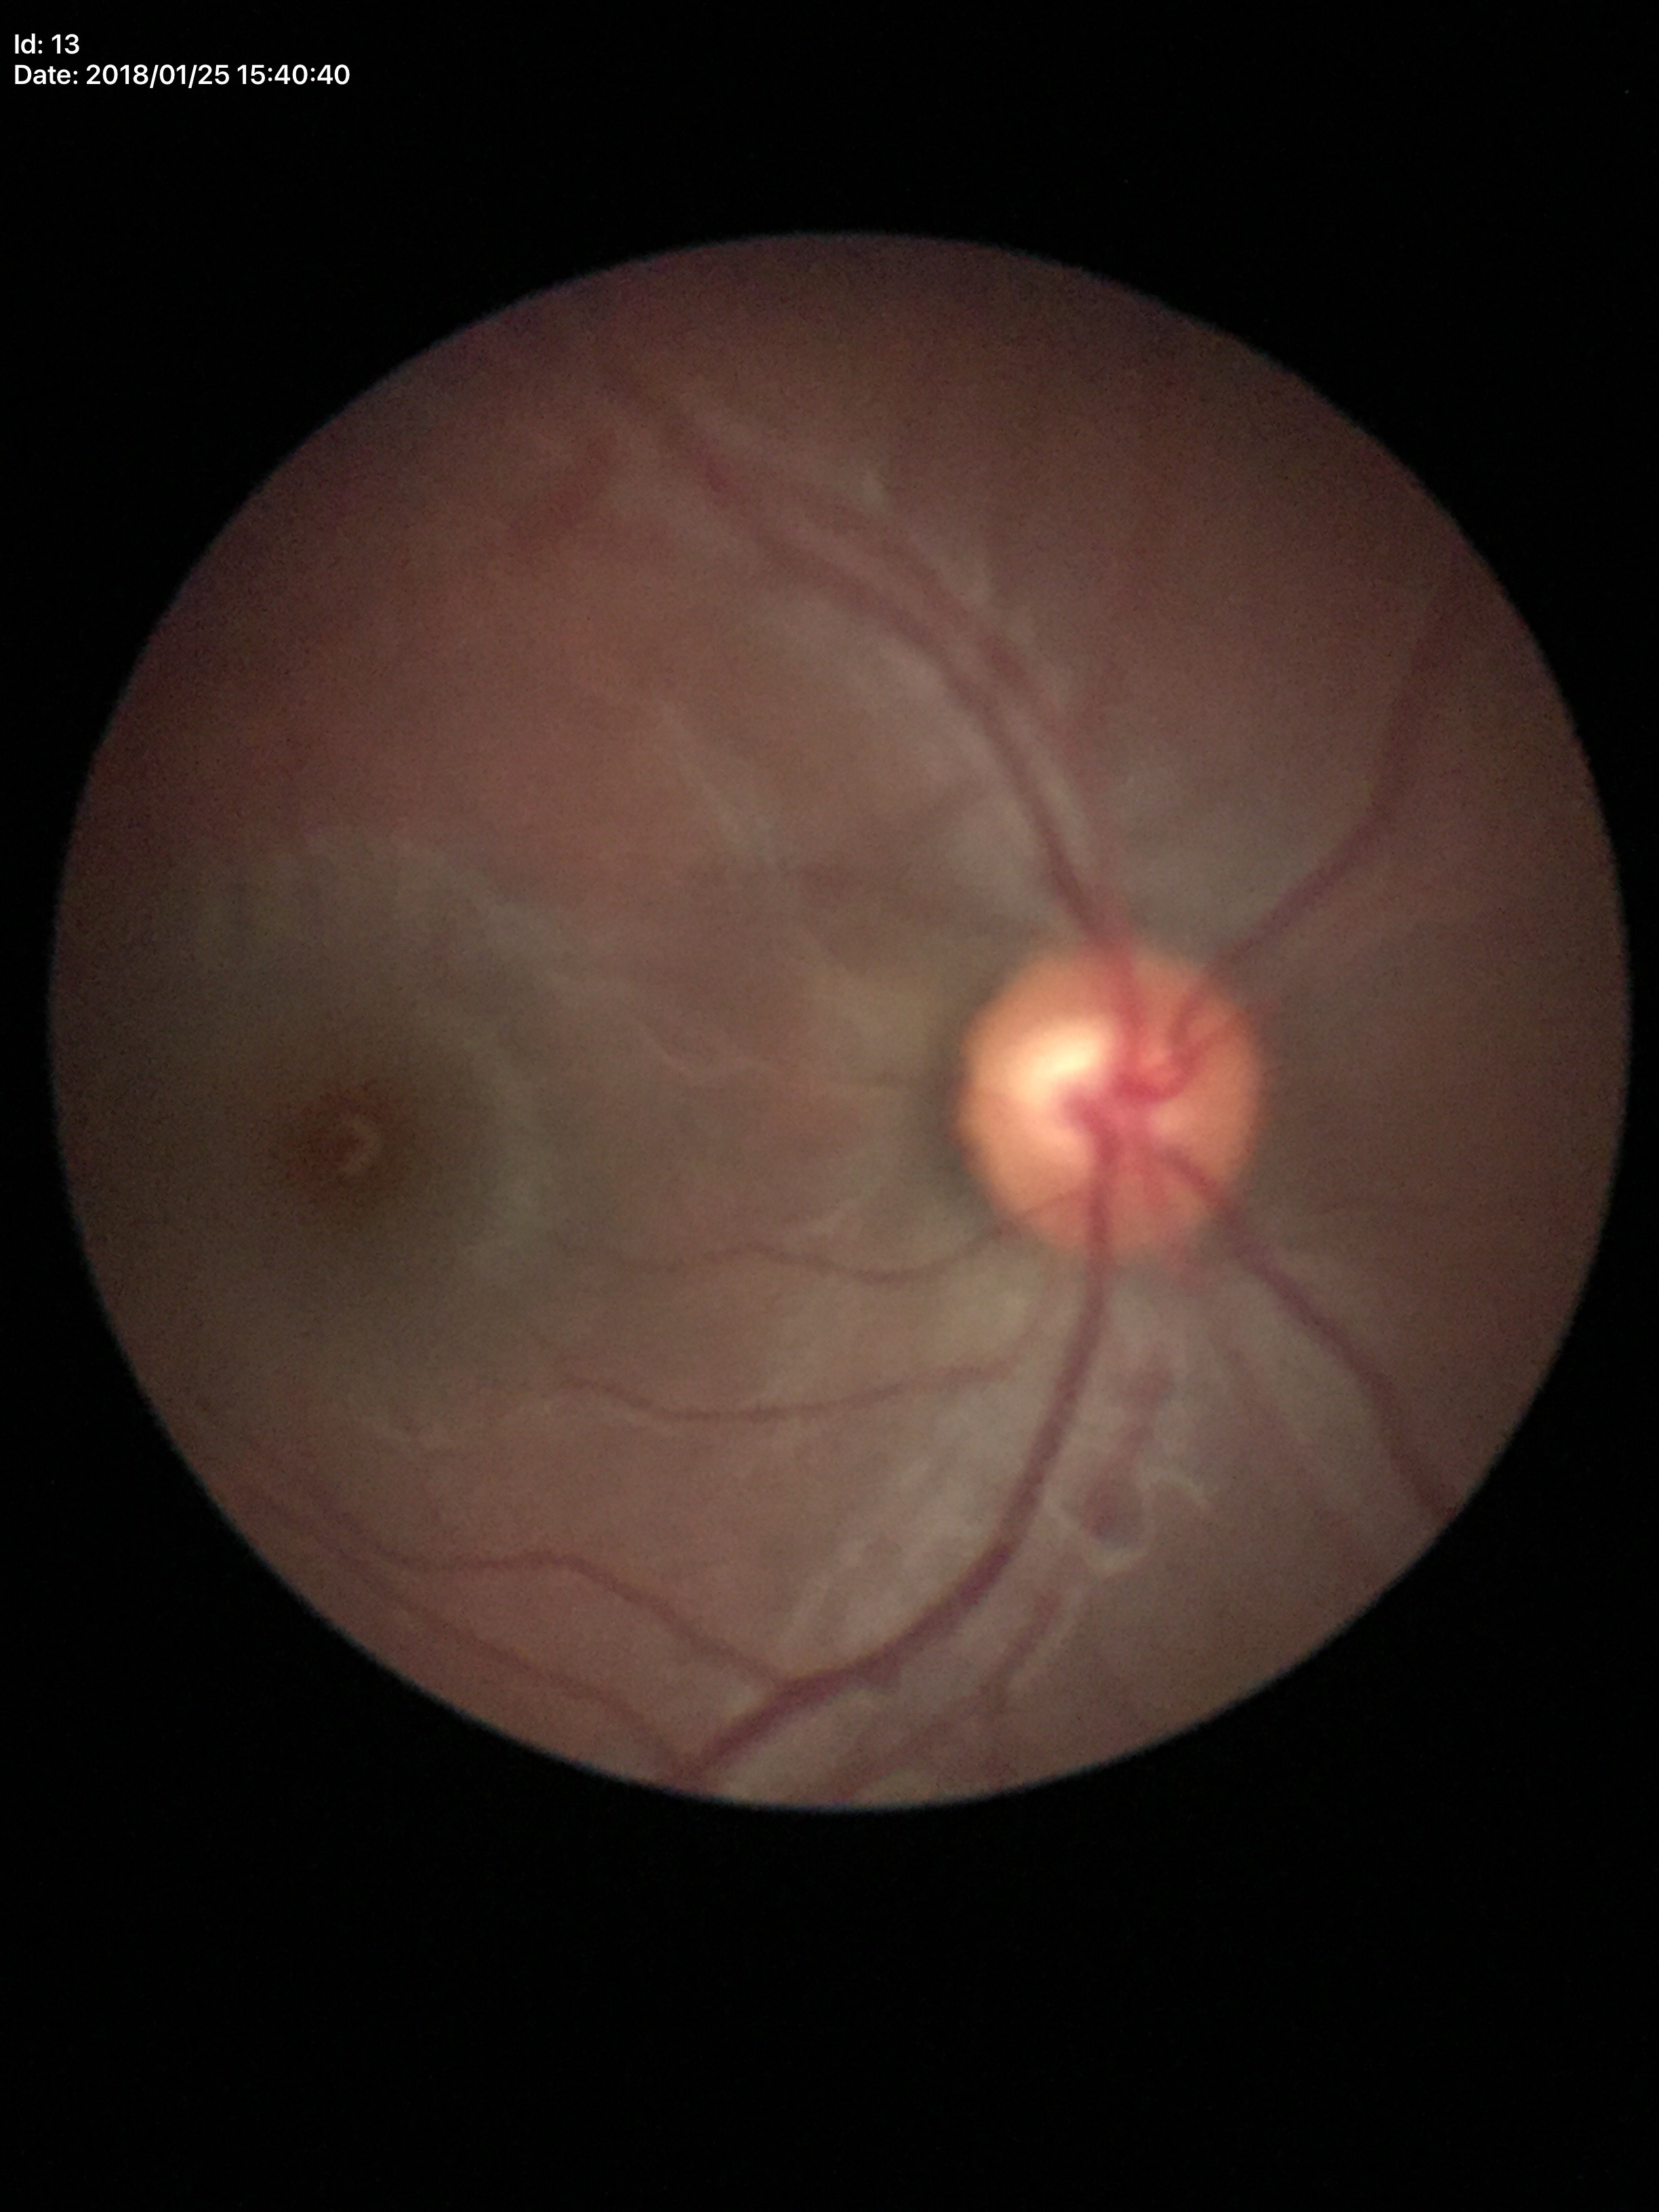

No evidence of glaucoma. Vertical C/D ratio (VCDR) of 0.56. Horizontal C/D ratio (HCDR): 0.61.